50° FOV; 1534x1534px; color fundus image
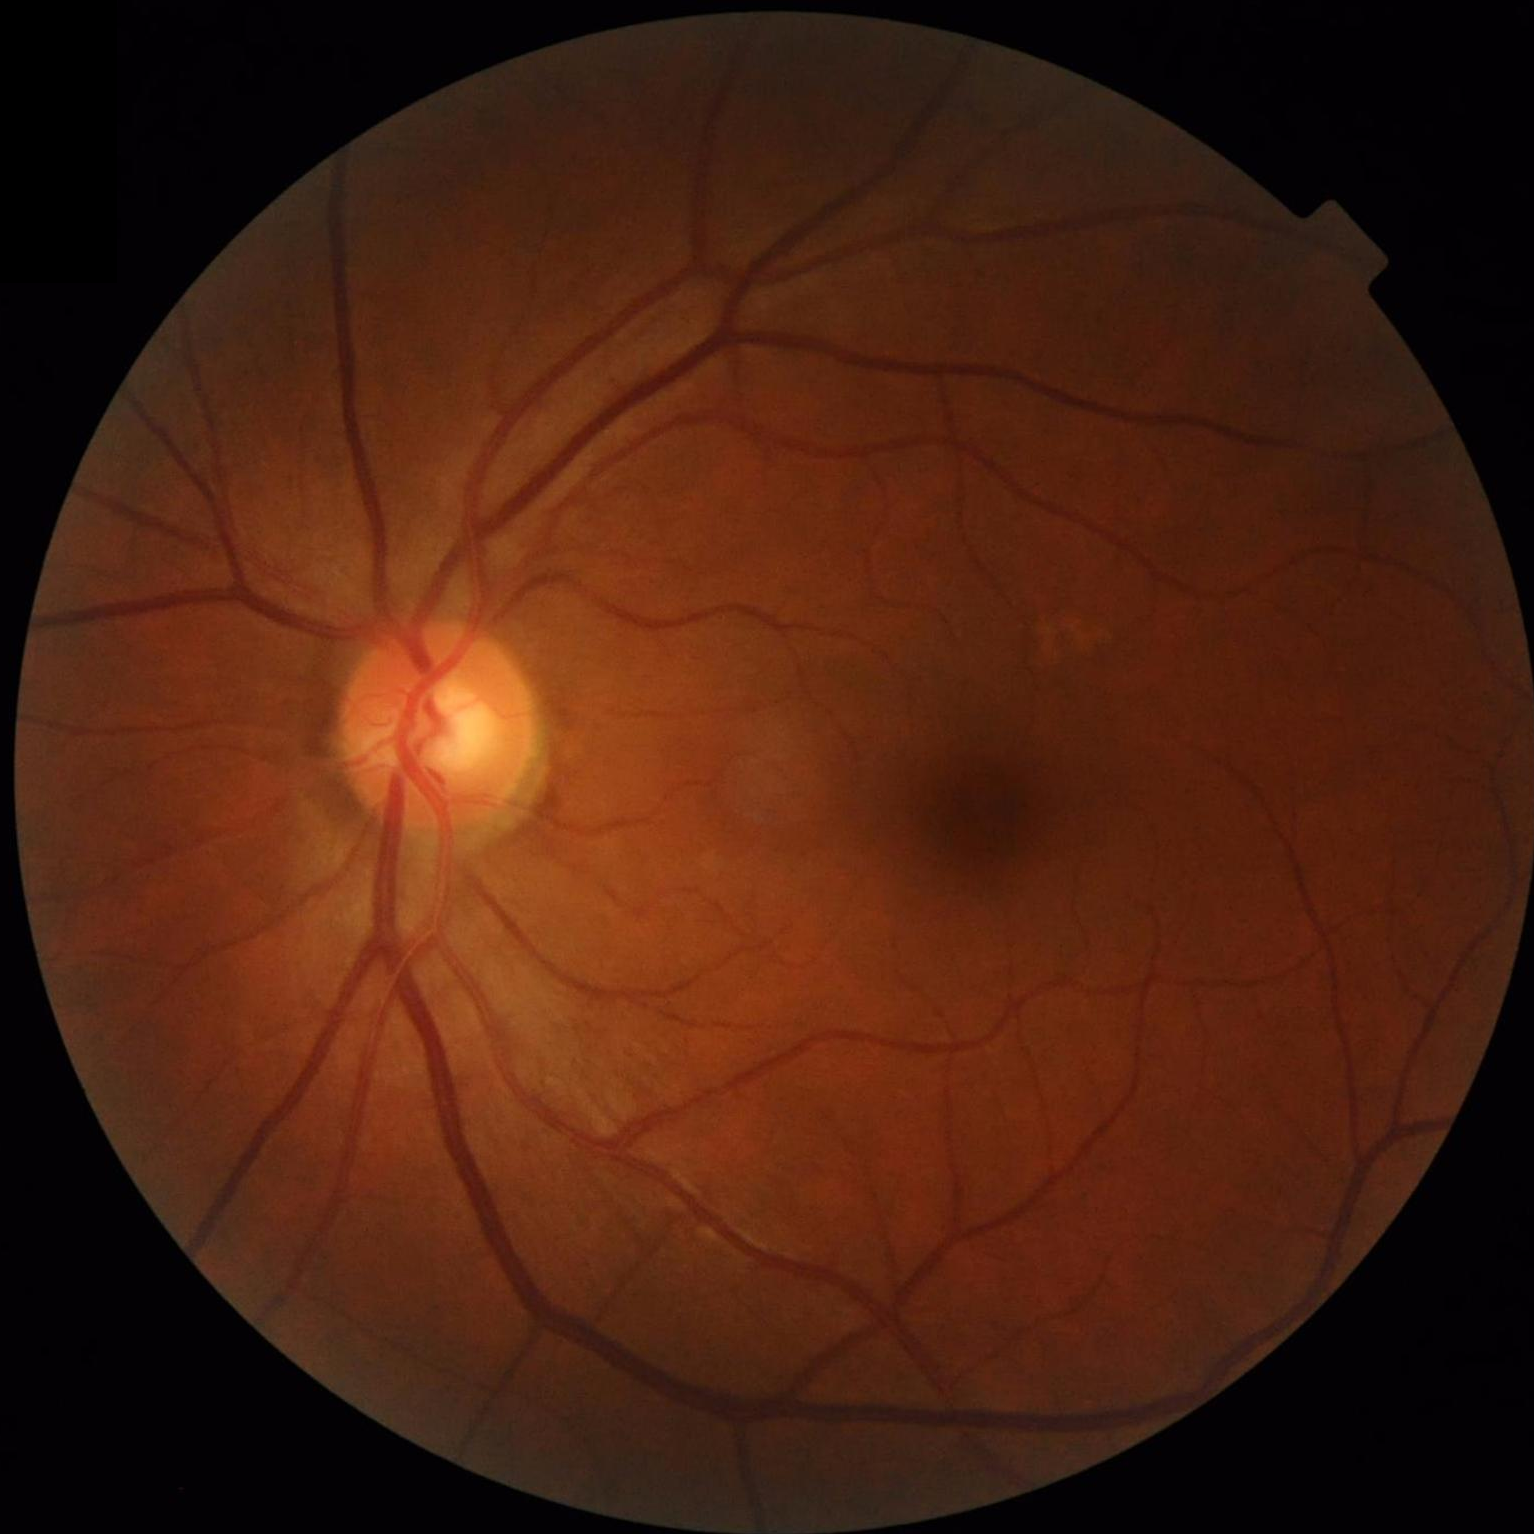

No noticeable blur. Acceptable image quality. Vessels and details are readily distinguishable.